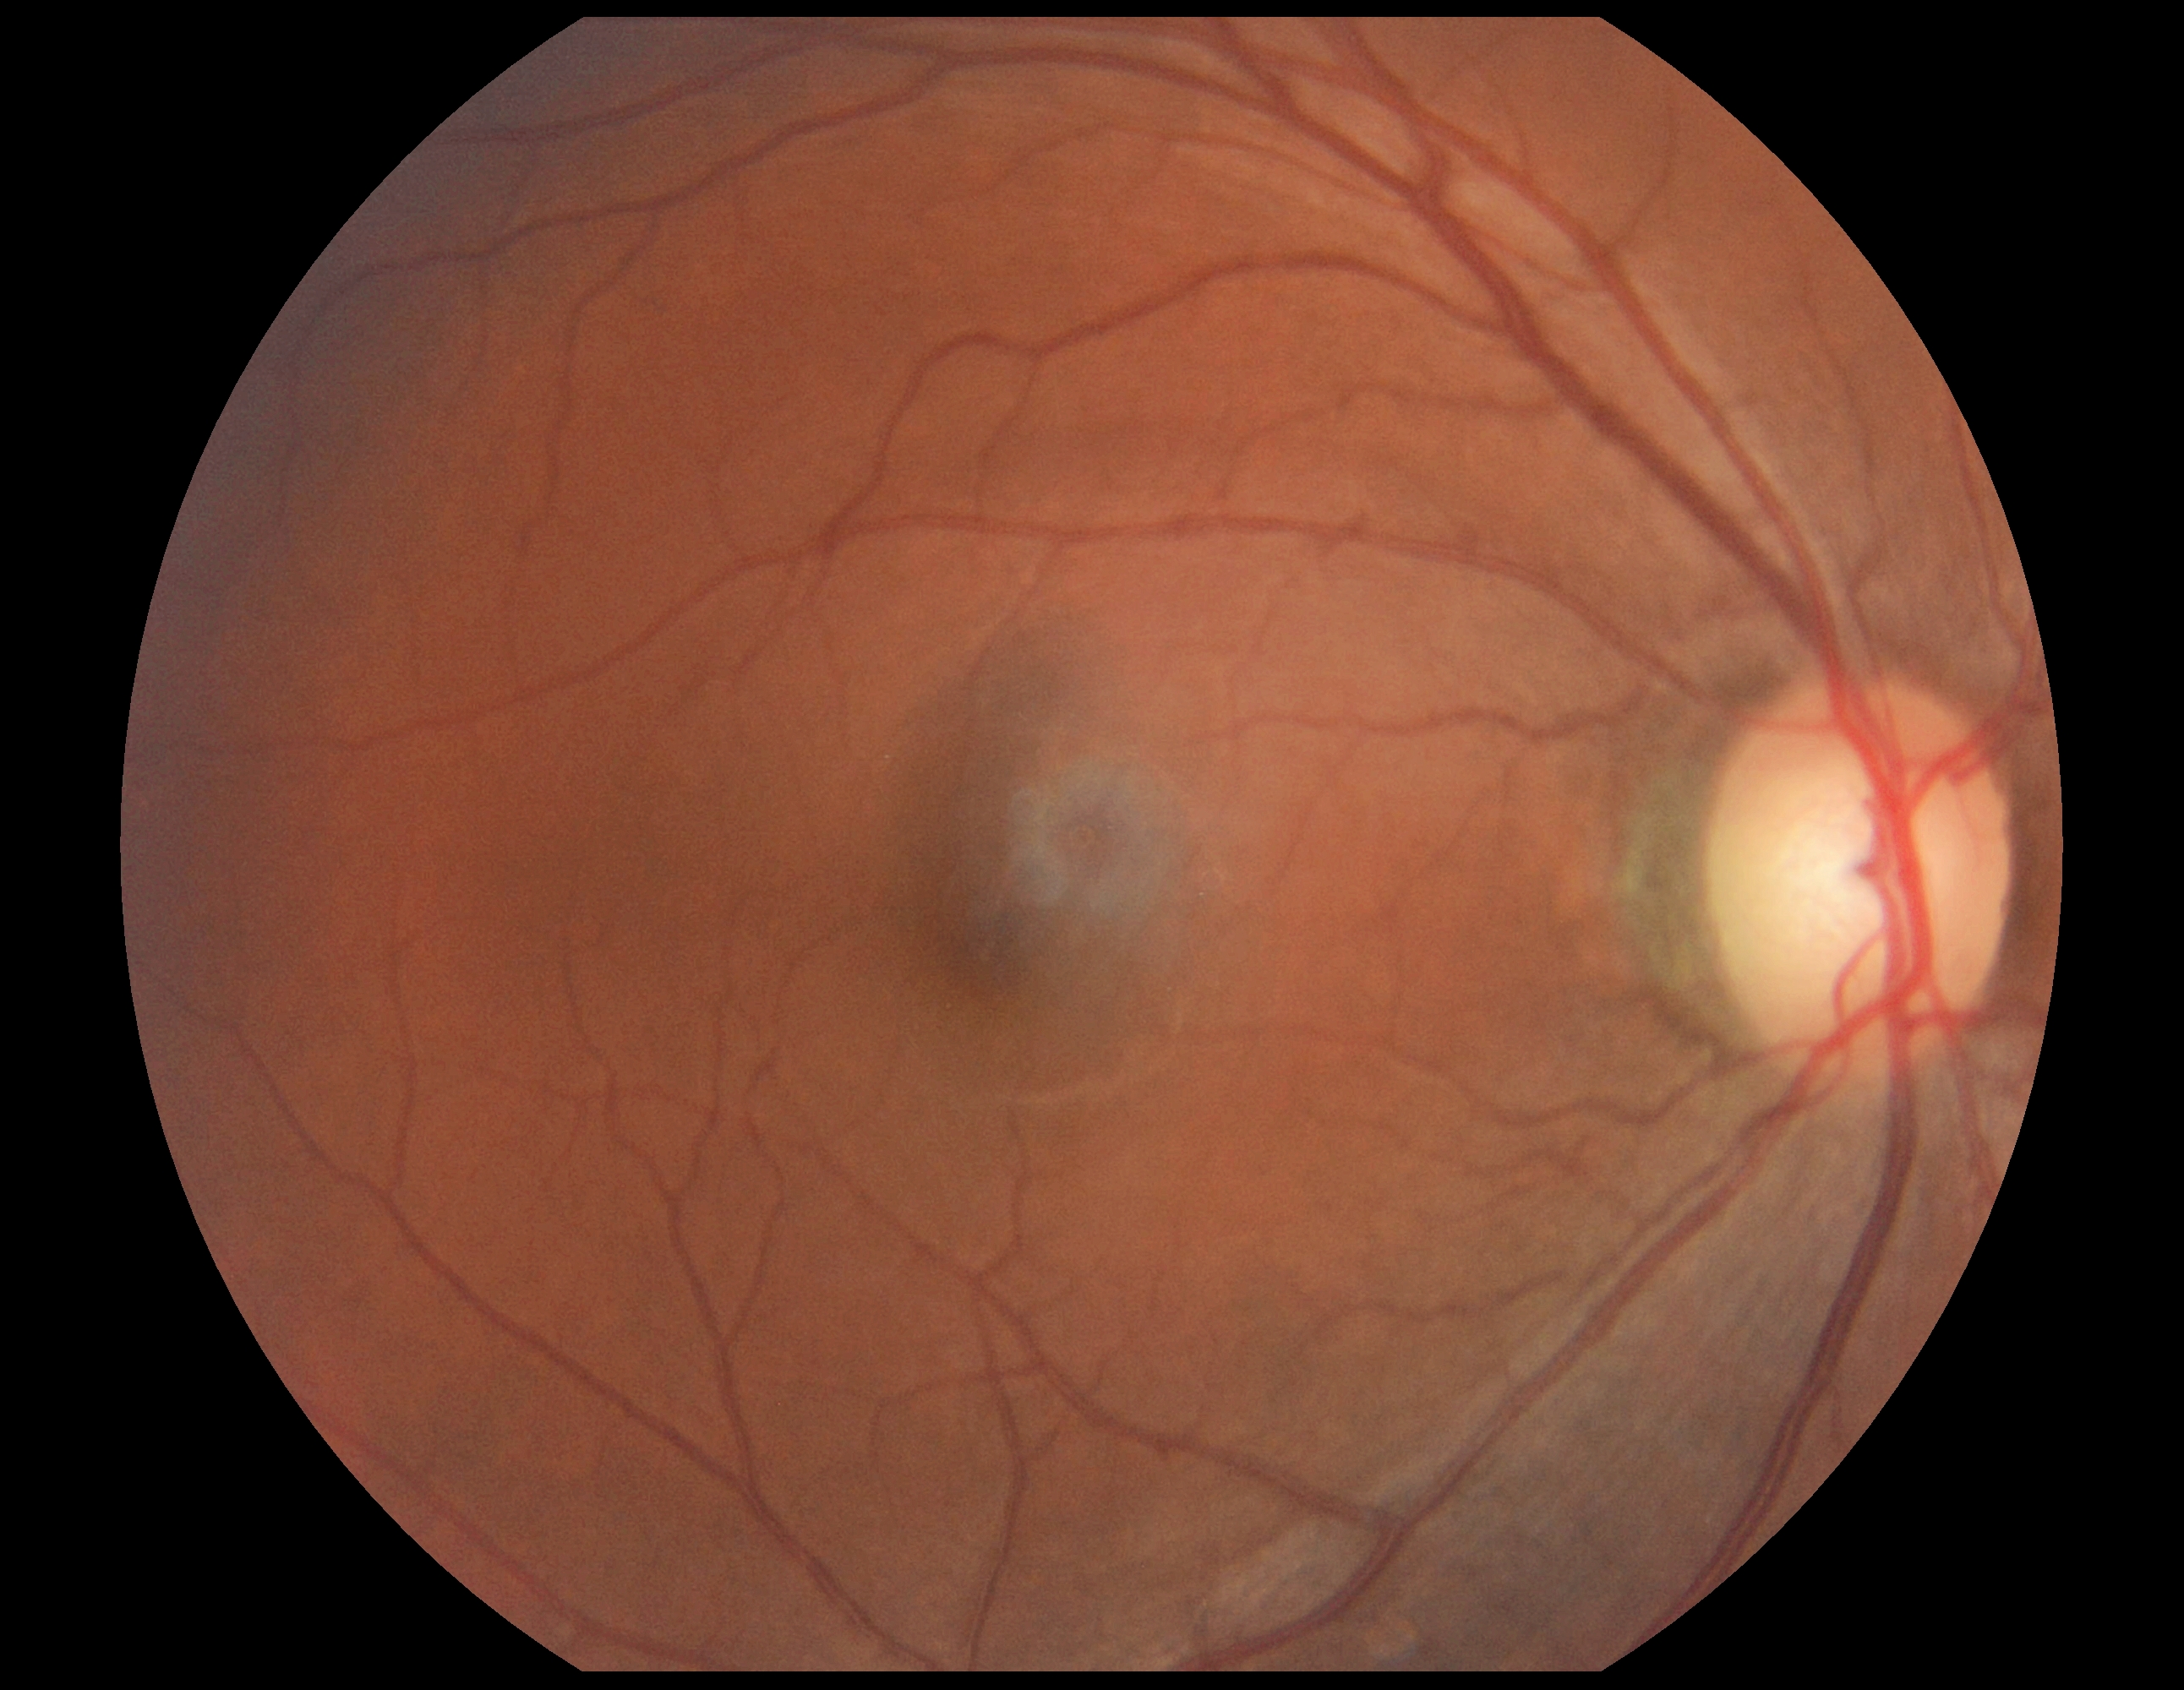

DR=0/4 — no visible signs of diabetic retinopathy.